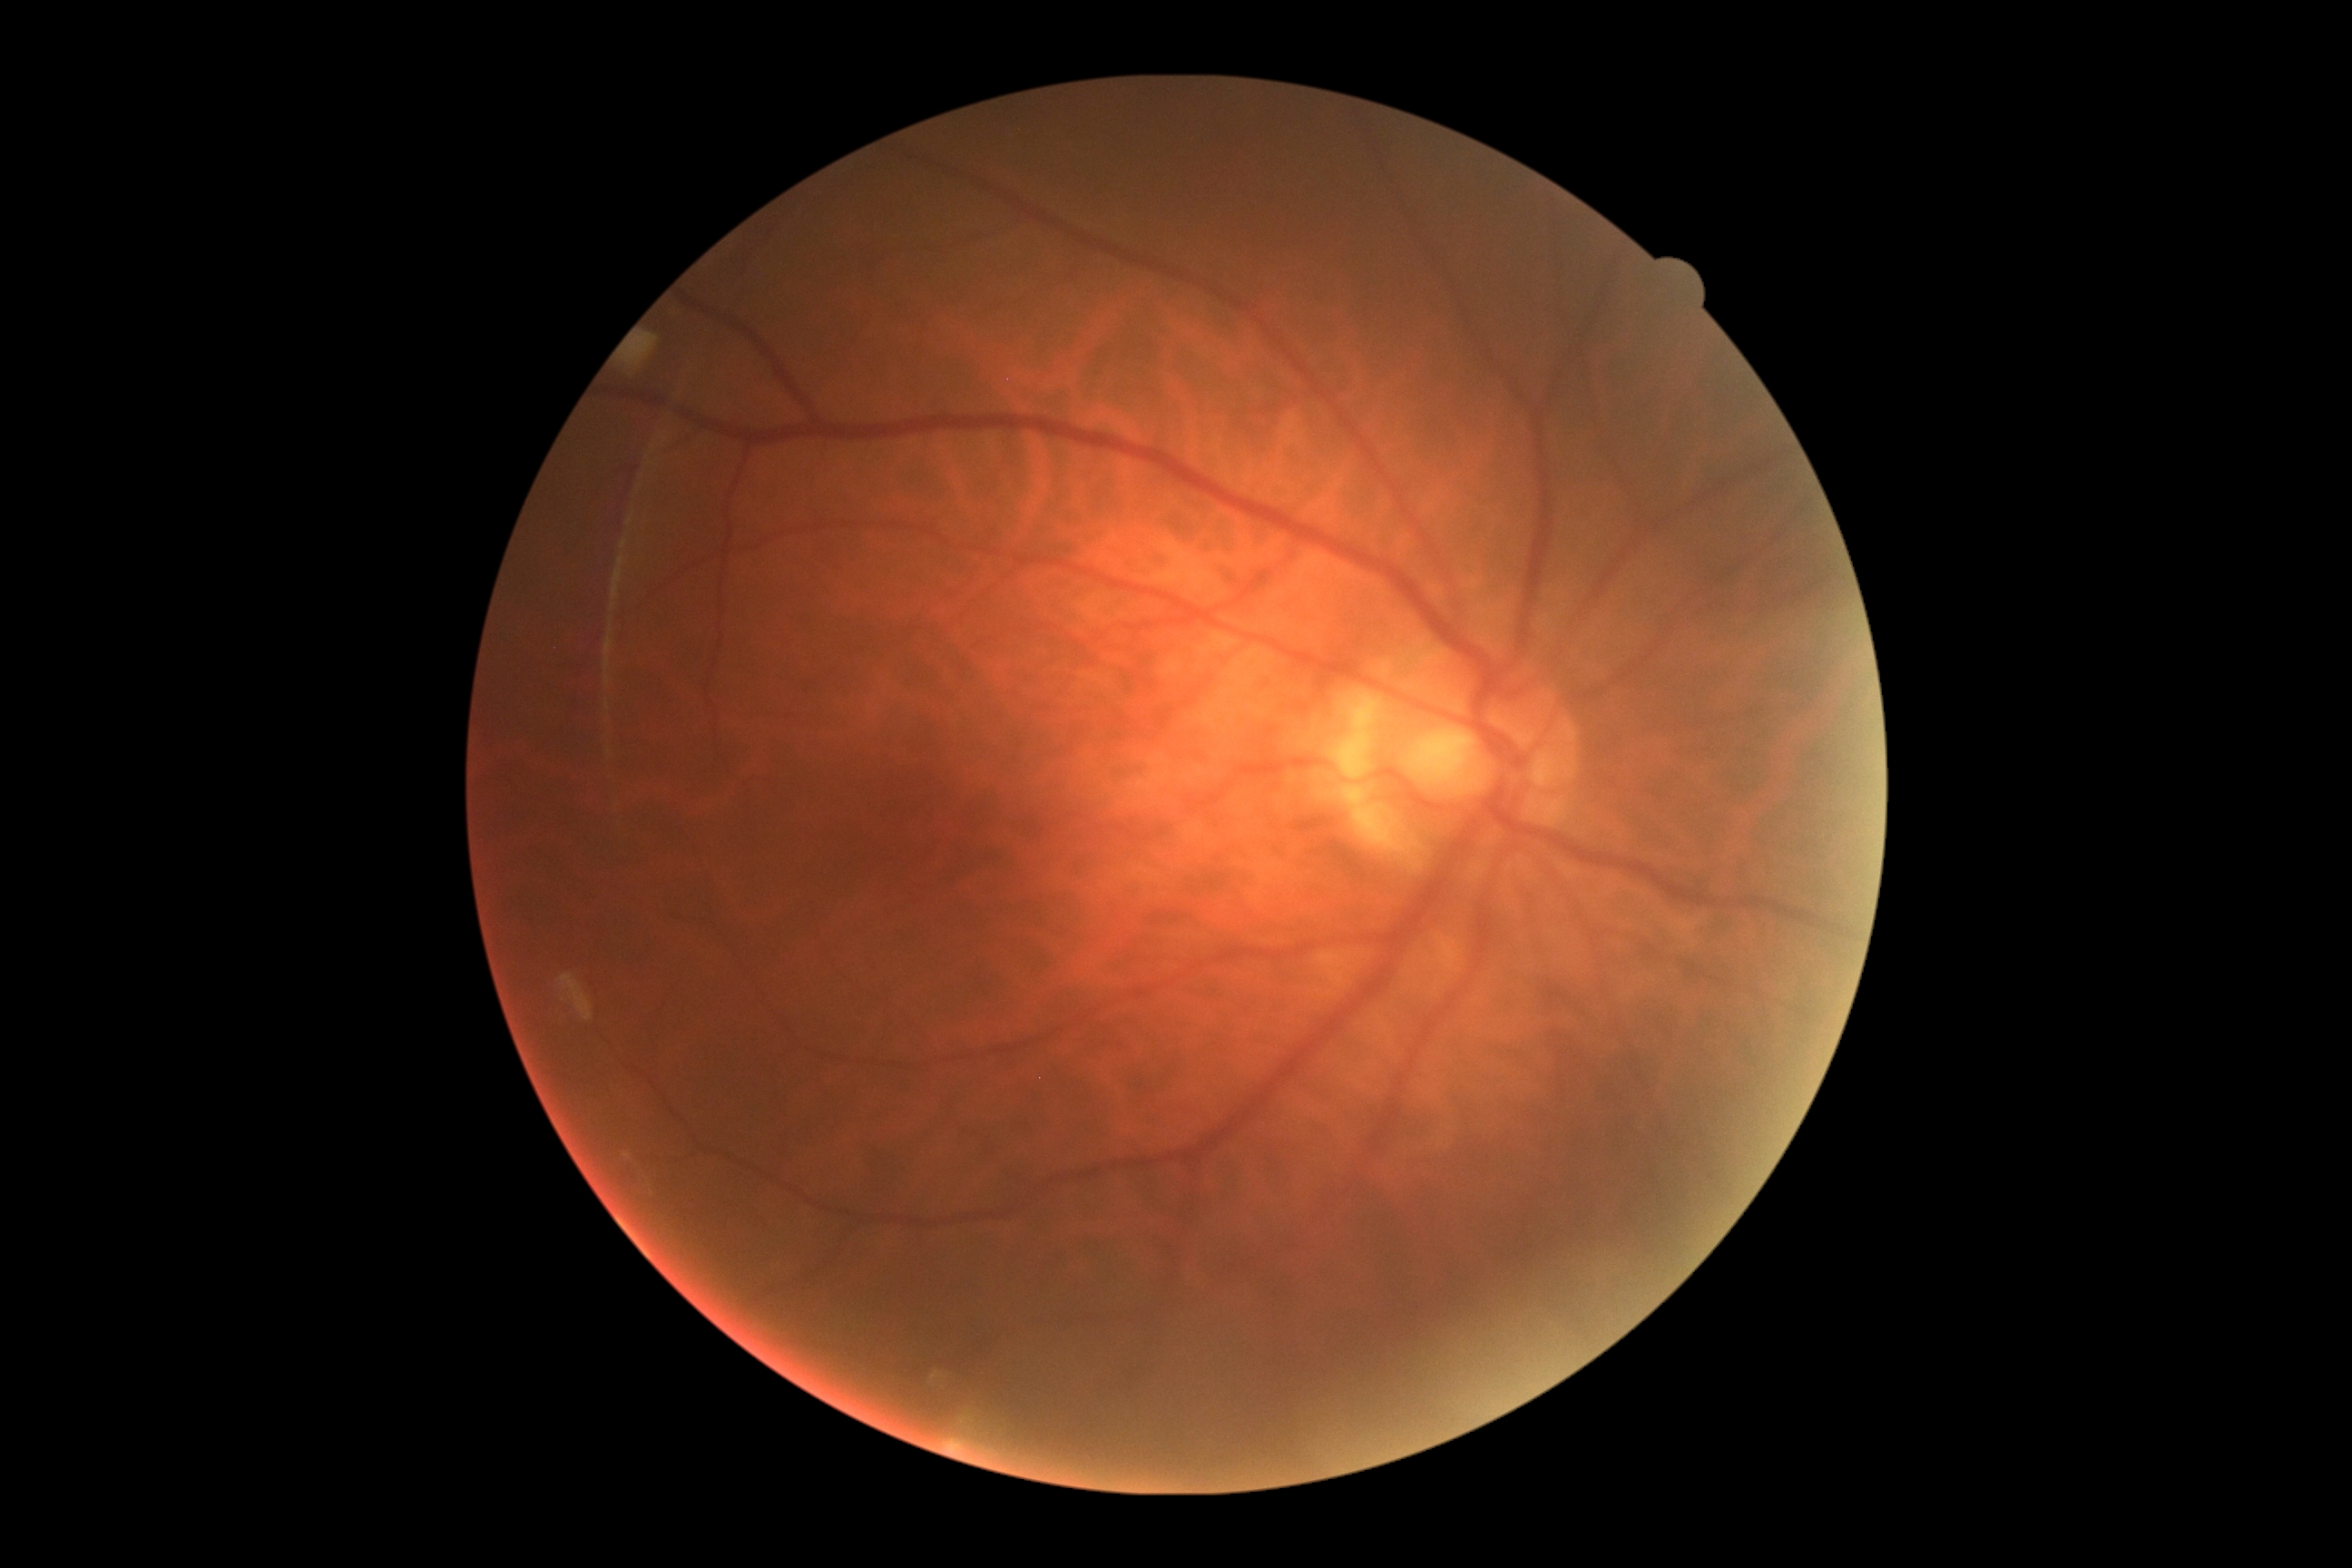 DR grade = 0